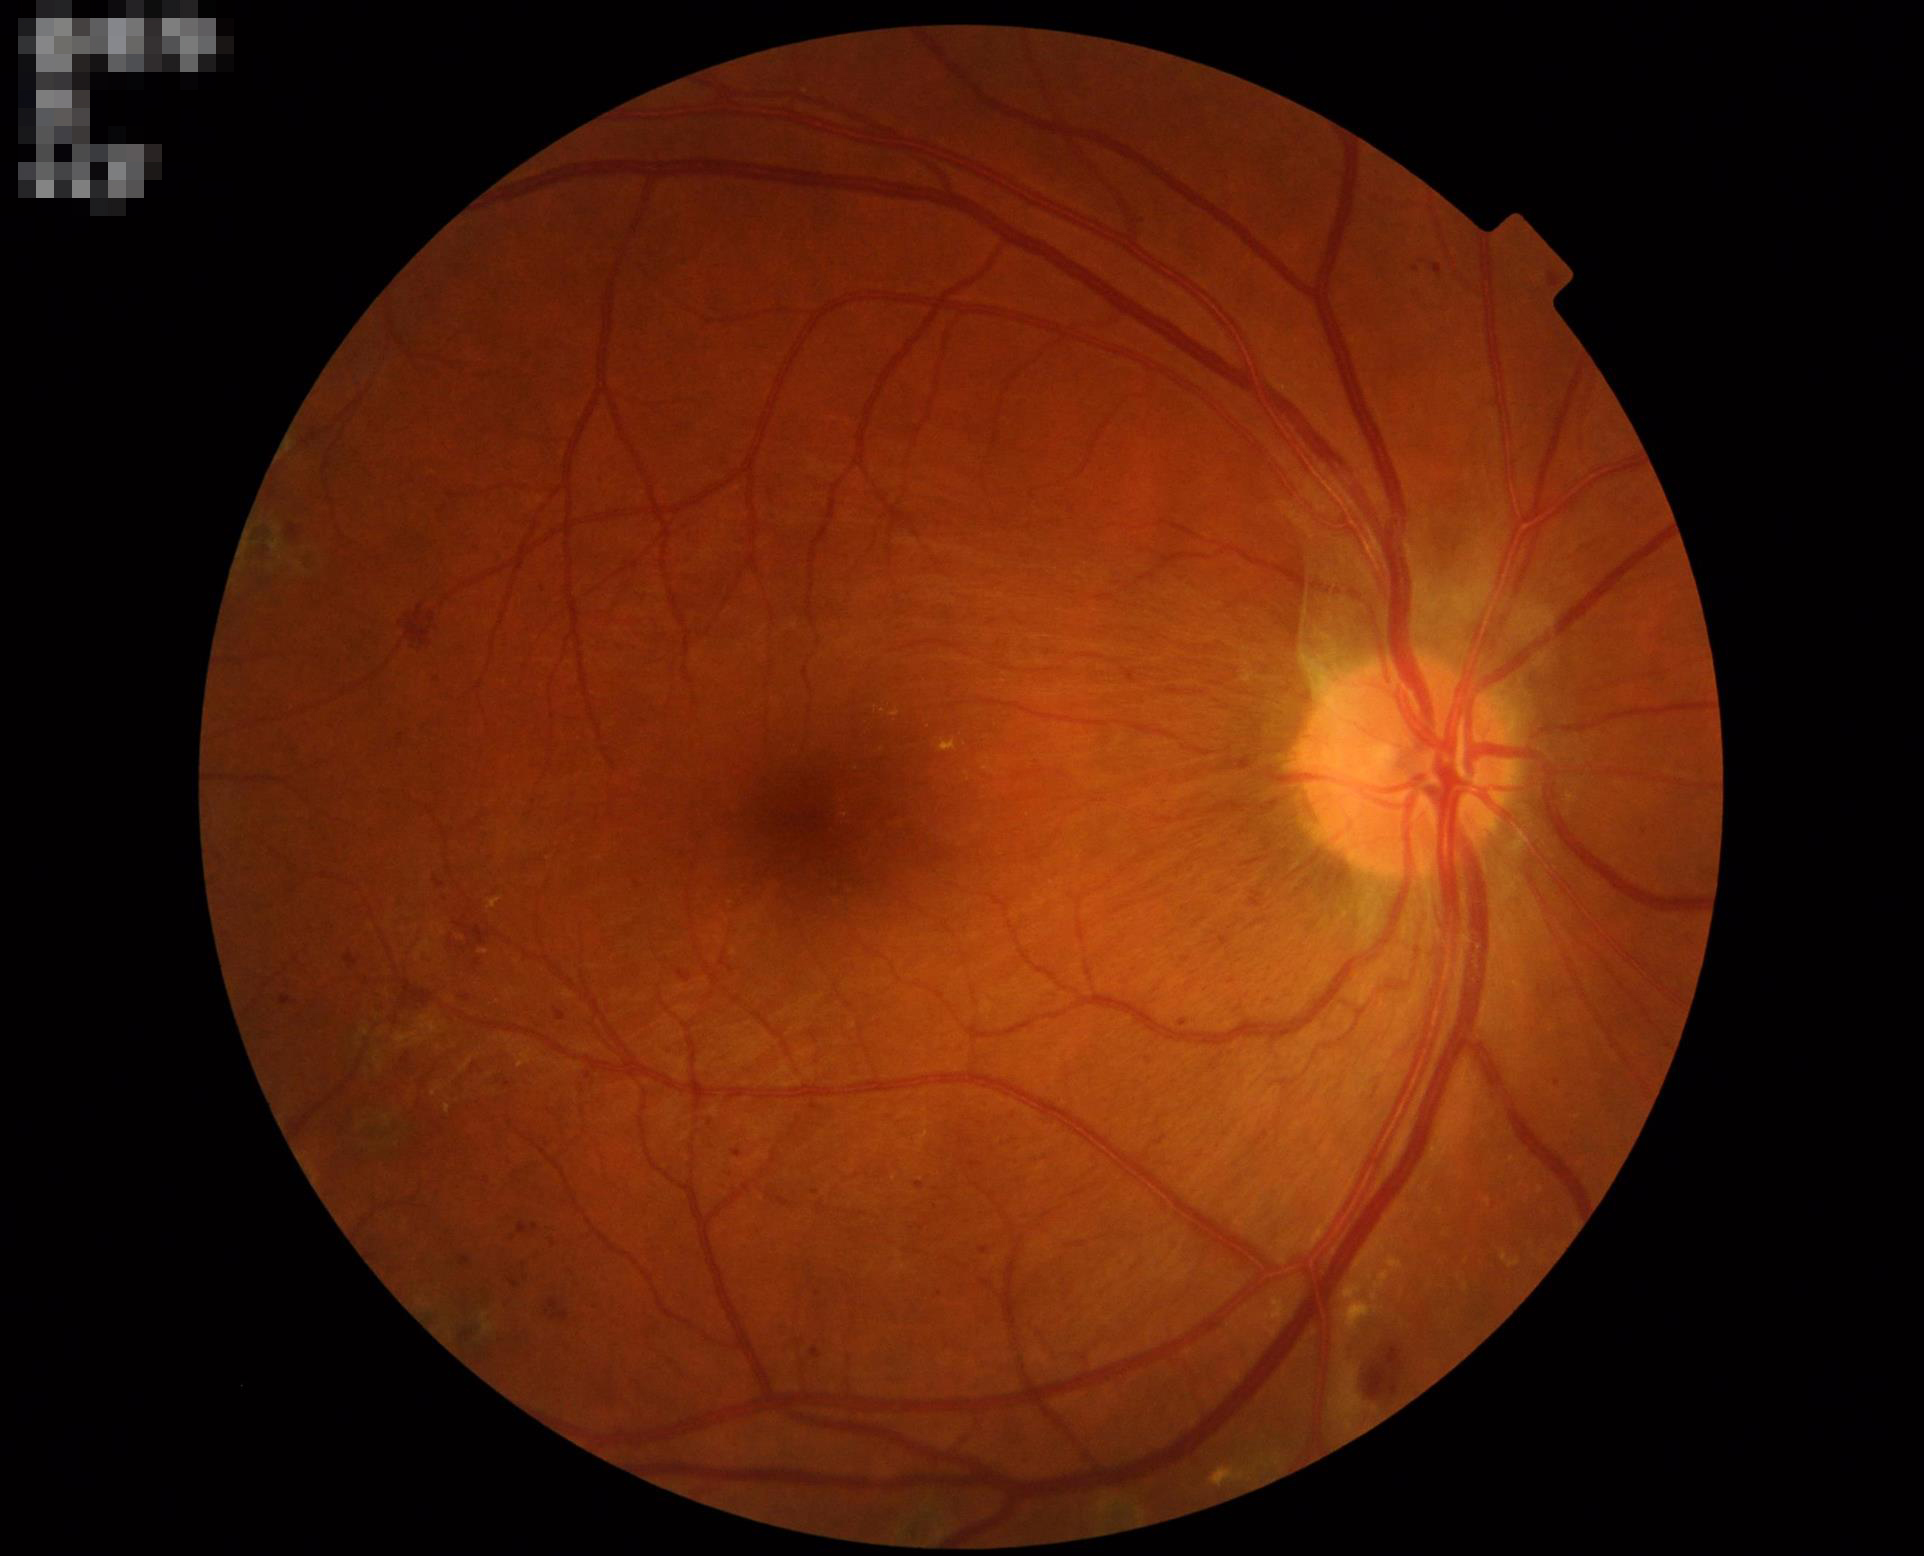 Image quality is adequate for diagnostic use. Illumination and color balance are good. No noticeable blur. Contrast is good.